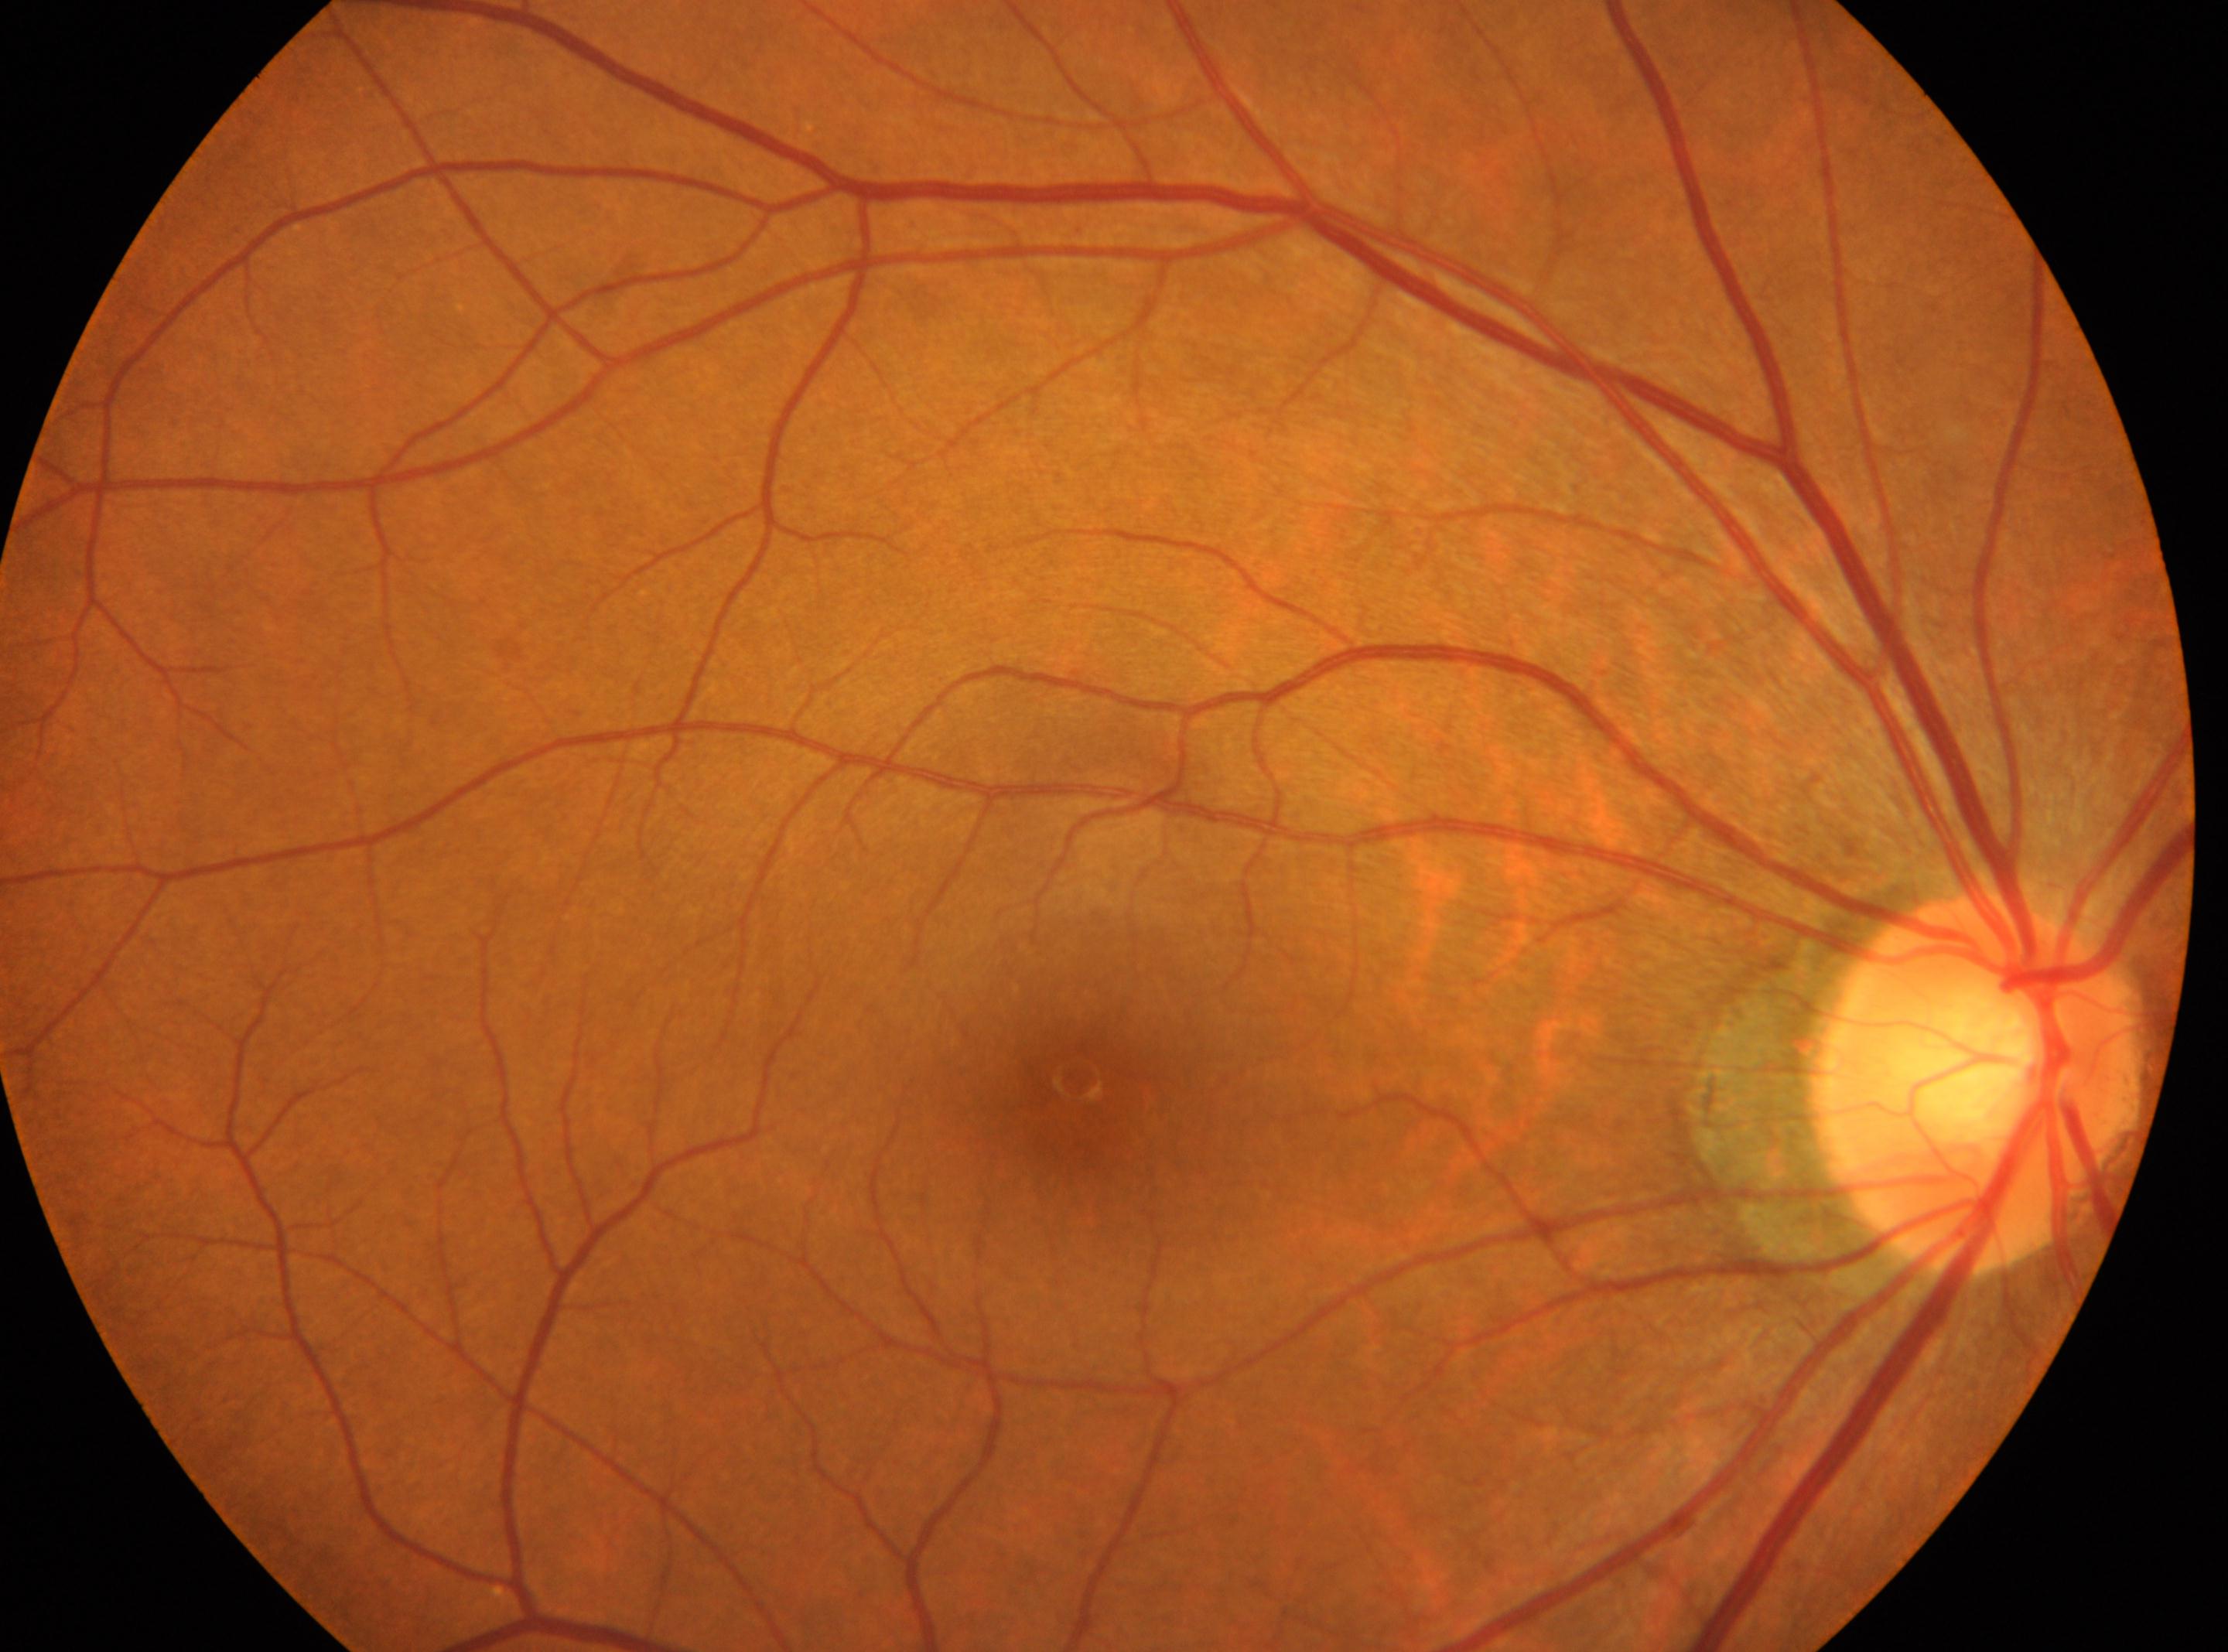

{"optic_disc": "(x=1979, y=1084)", "fovea": "(x=1078, y=1081)", "eye": "OD", "dr_grade": "0 (no apparent retinopathy) — no visible signs of diabetic retinopathy"}